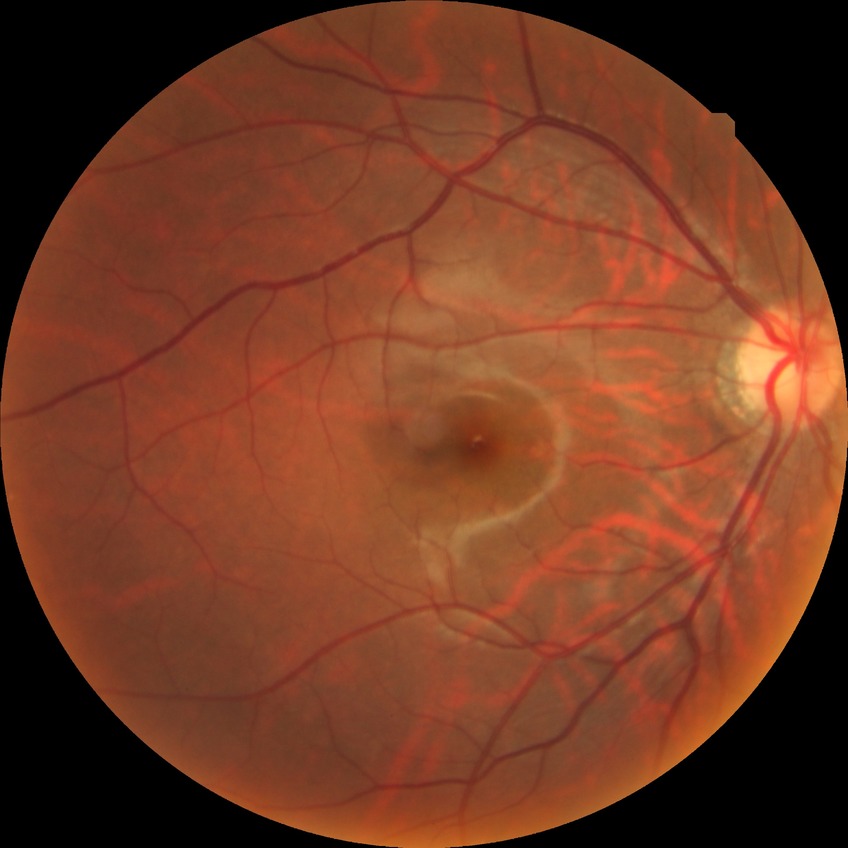
– DR impression: no DR findings
– DR: NDR